1932 by 1910 pixels · 45° field of view · CFP — 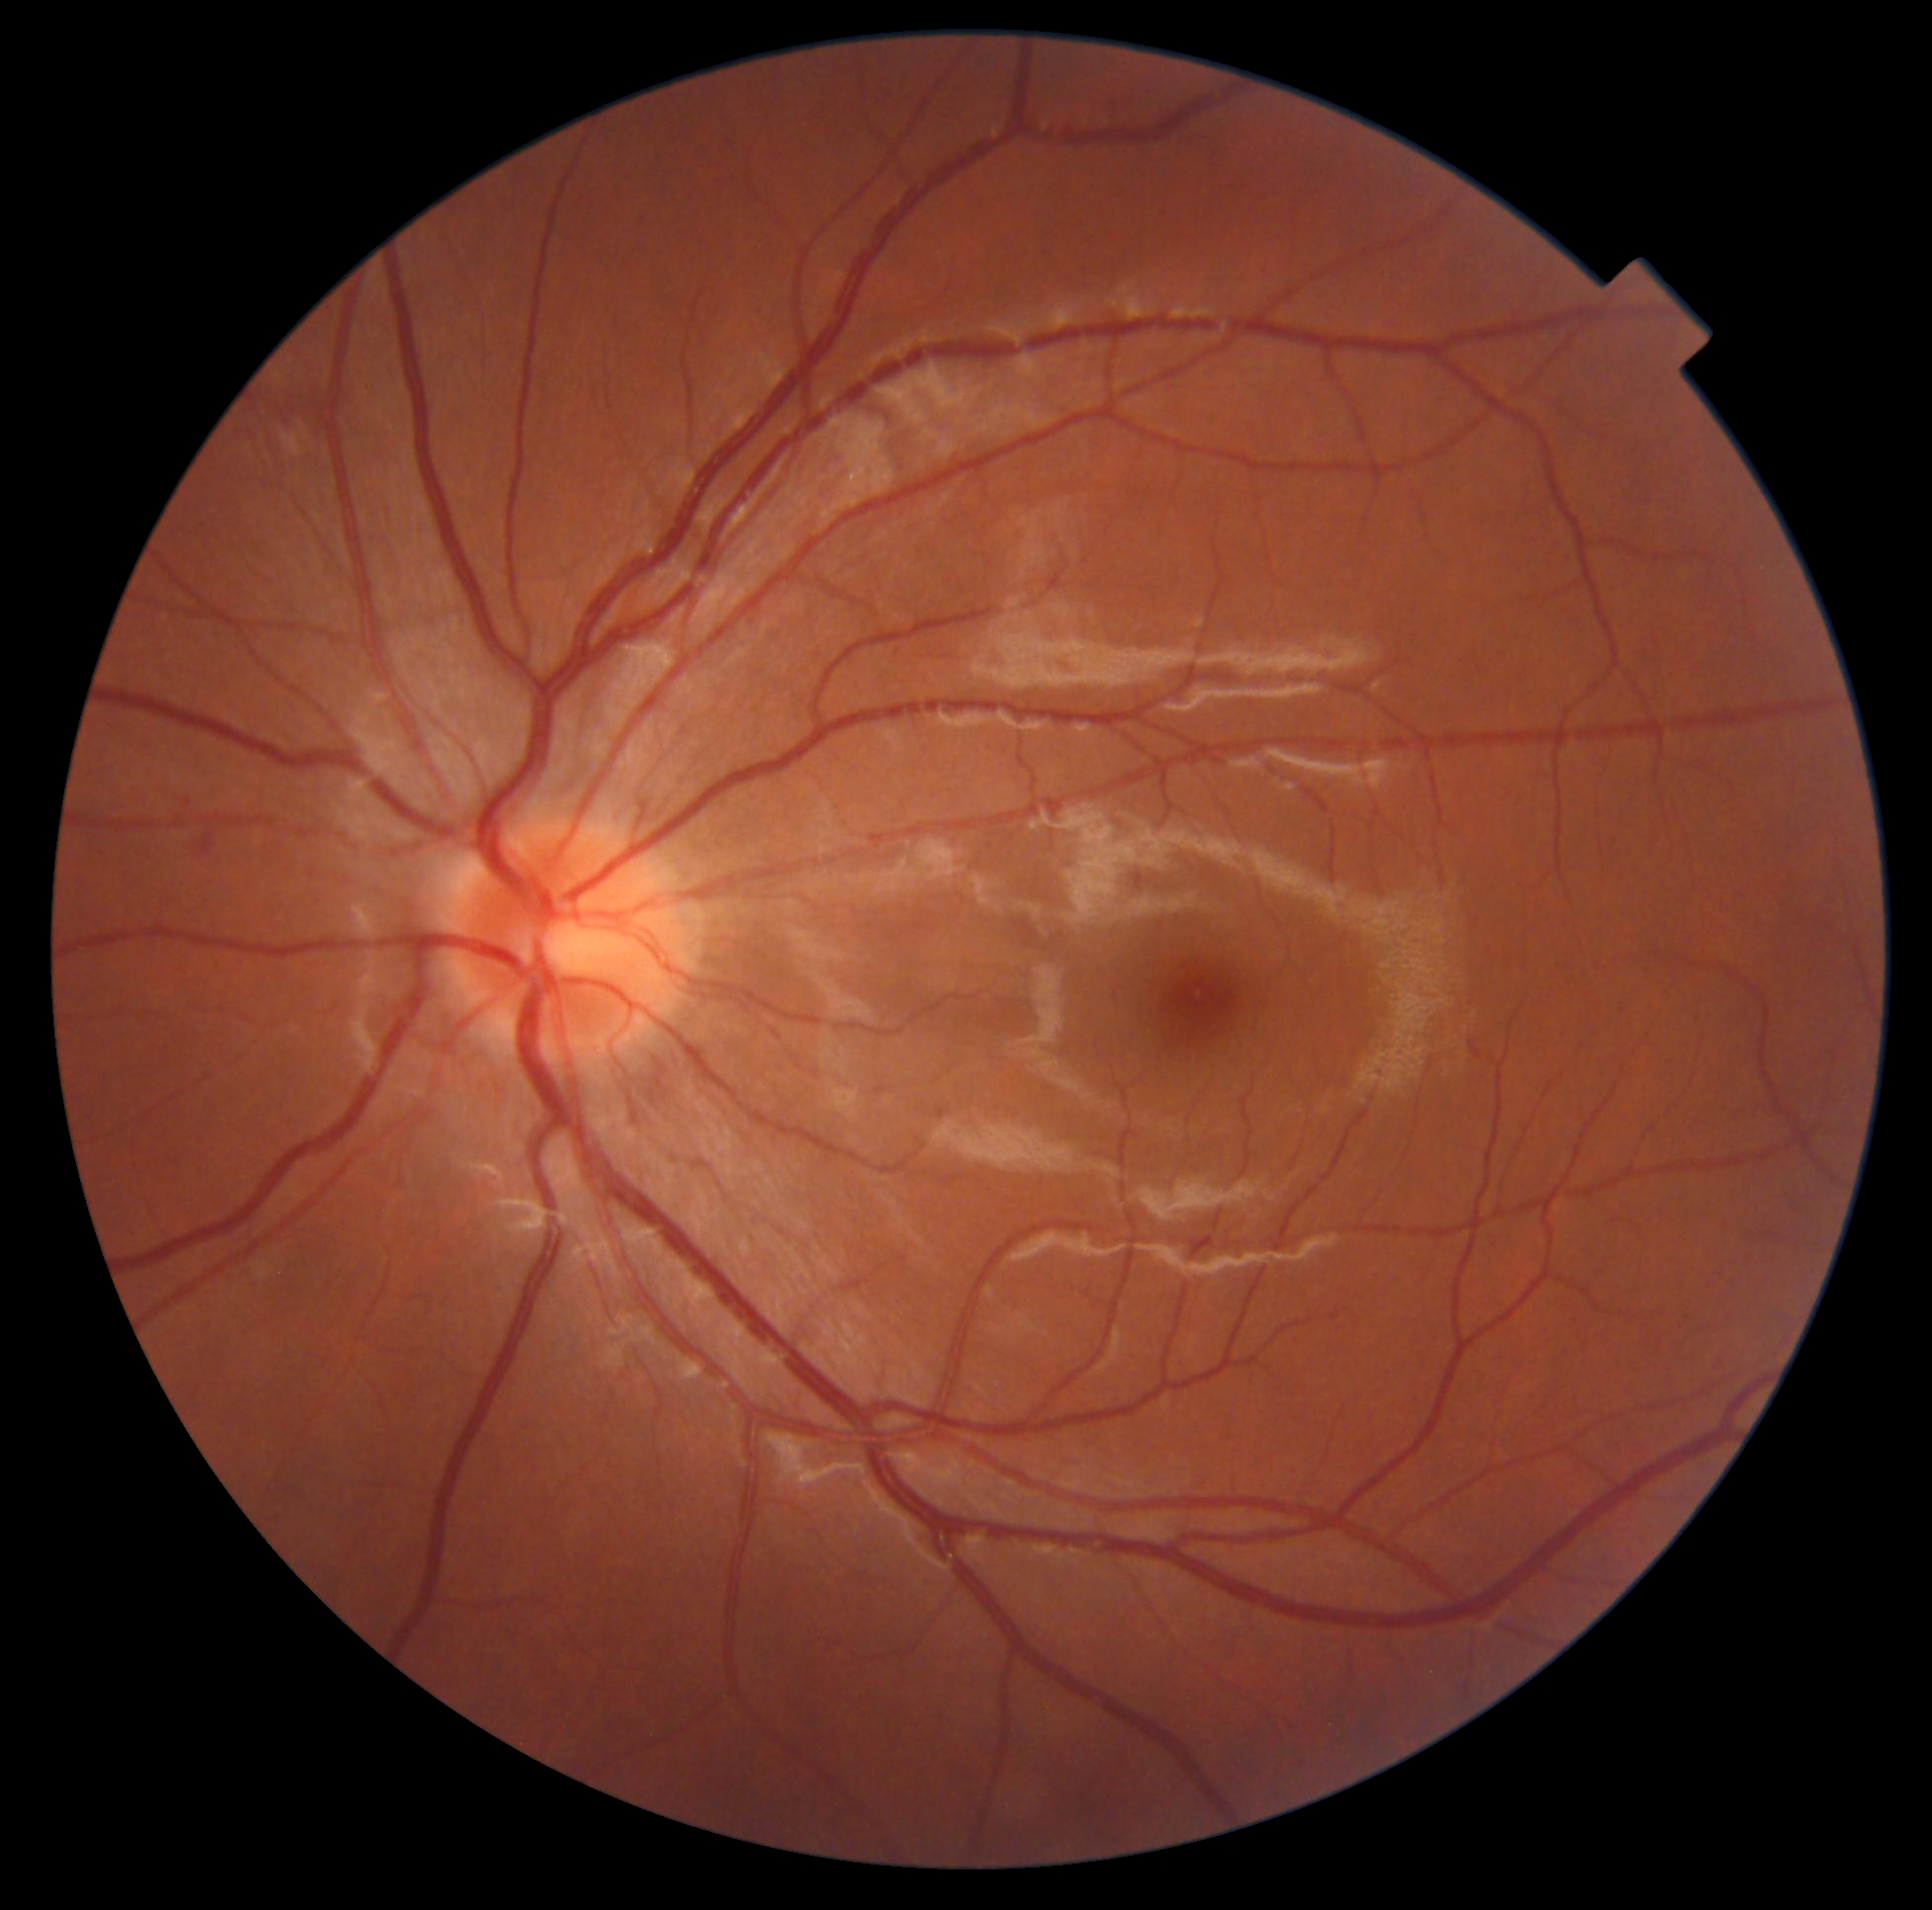
DR grade is 2/4.